Posterior pole view.
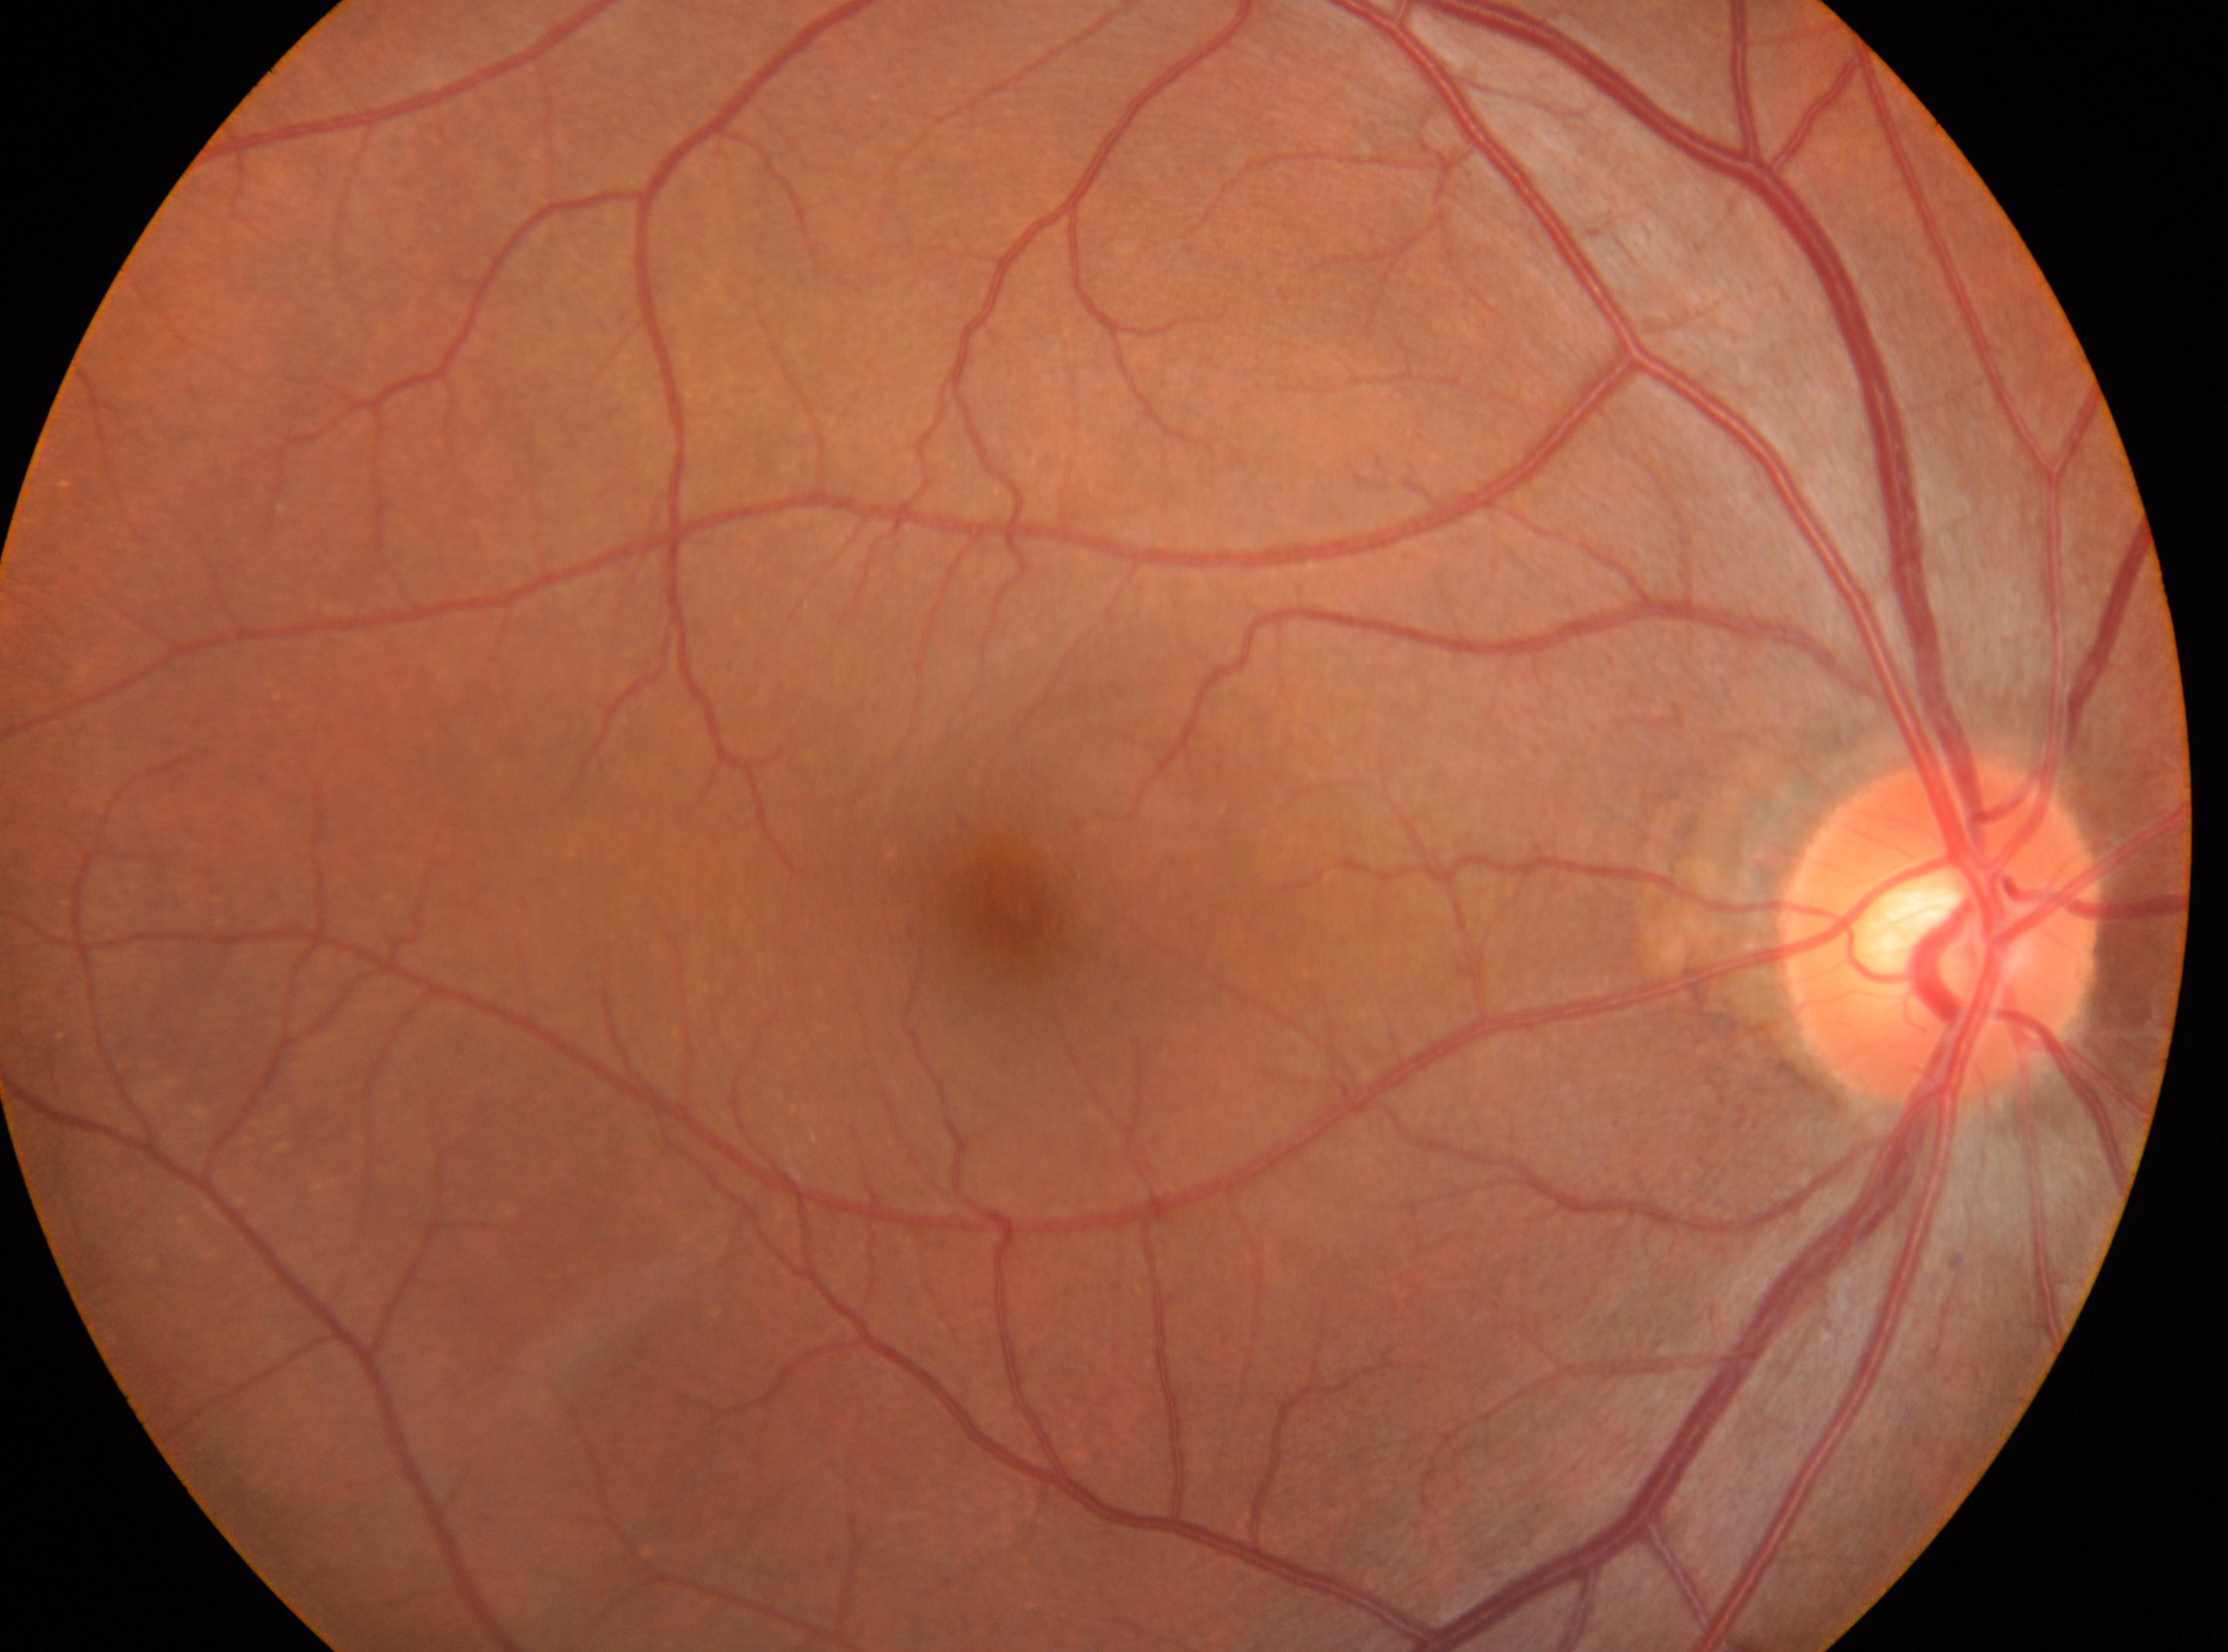 DR grade@0; right eye; fovea center@x=1007, y=910; optic nerve head@x=1941, y=930.